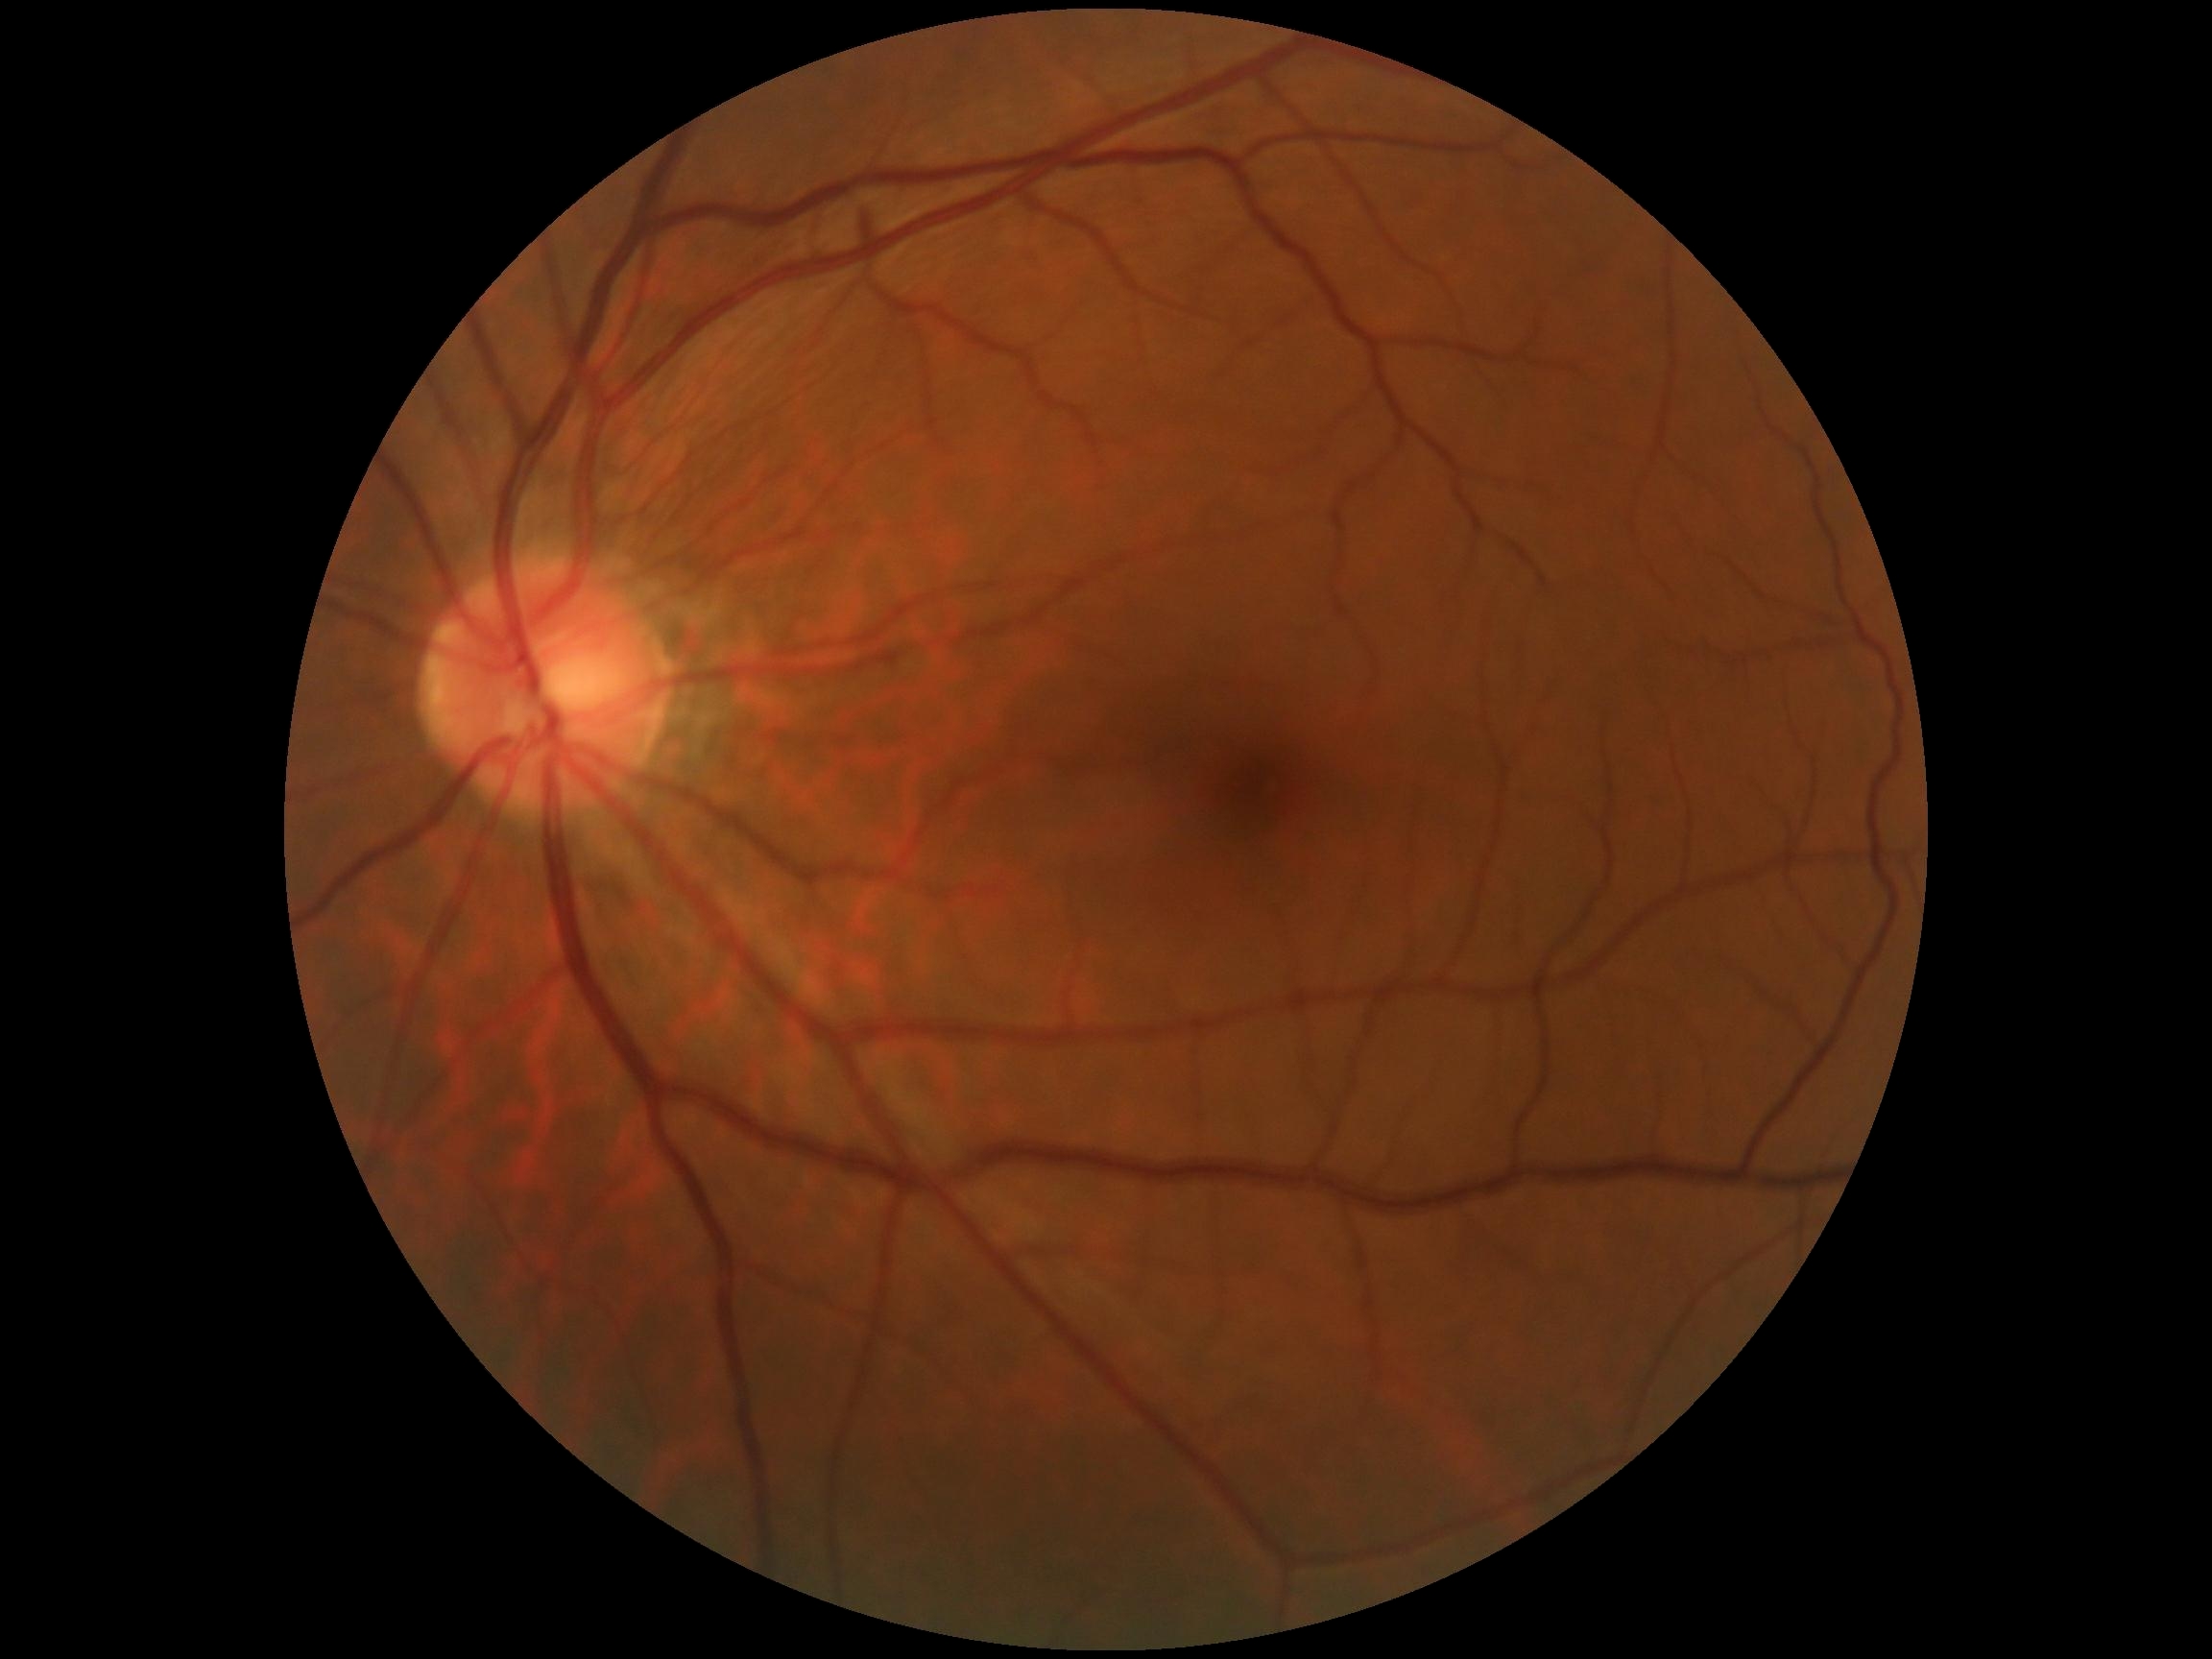

Retinopathy grade is 0.
No apparent diabetic retinopathy.